Pediatric retinal photograph (wide-field):
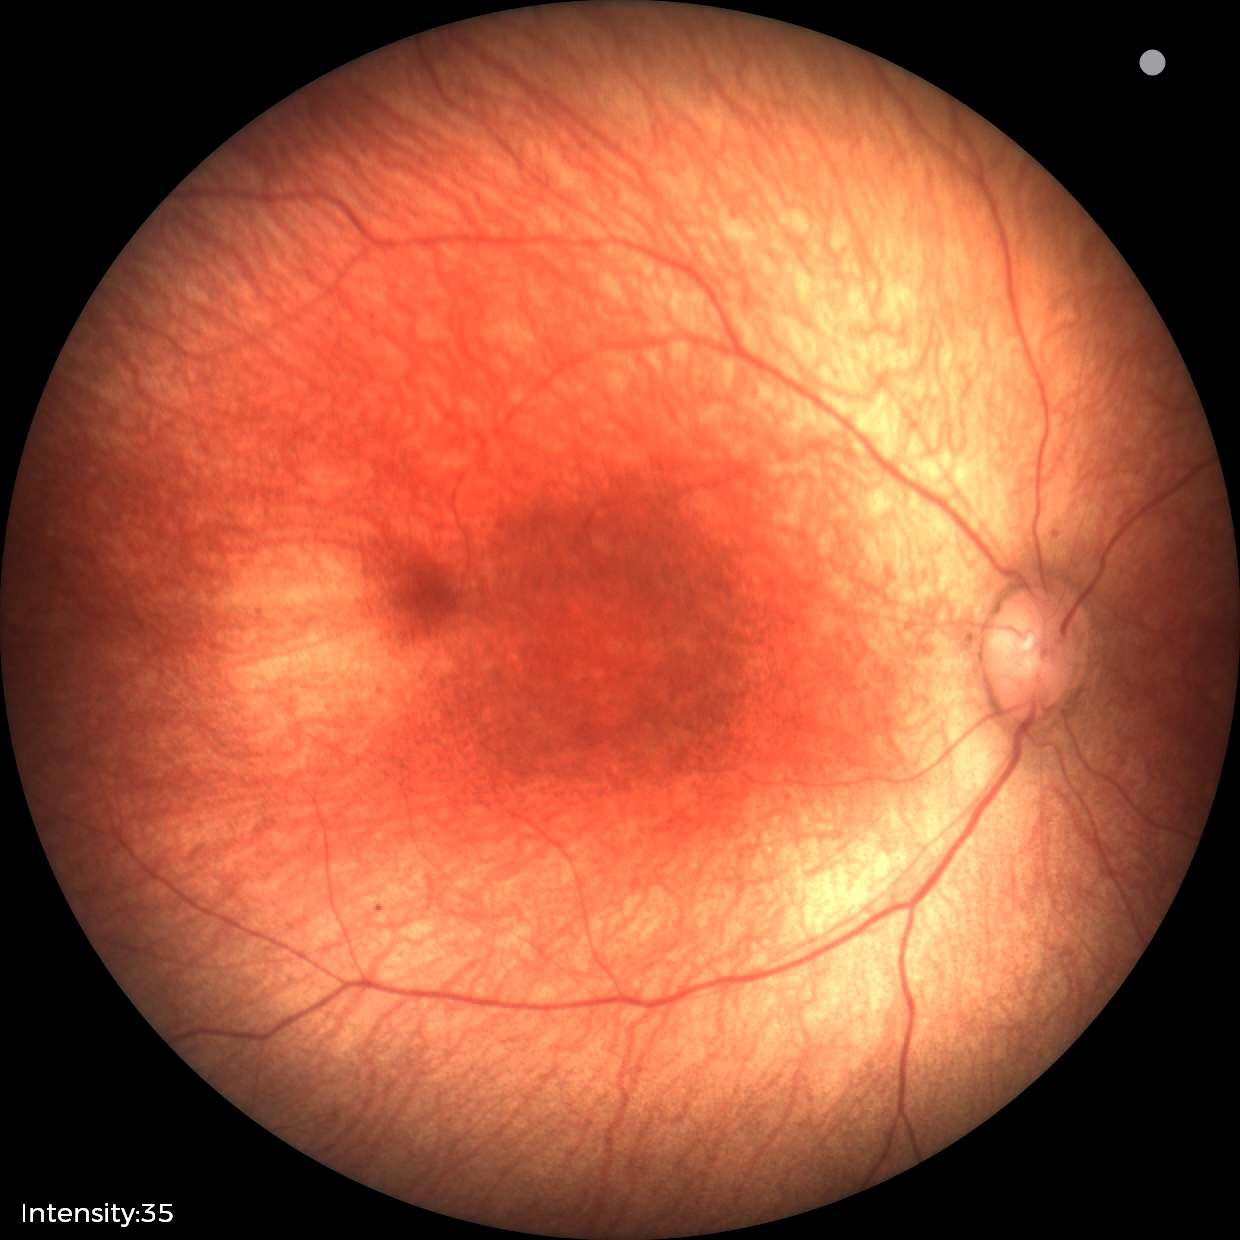 Impression: physiological appearance with no retinal pathology.